Wide-field fundus image from infant ROP screening · captured with the Clarity RetCam 3 (130° field of view) · 640x480.
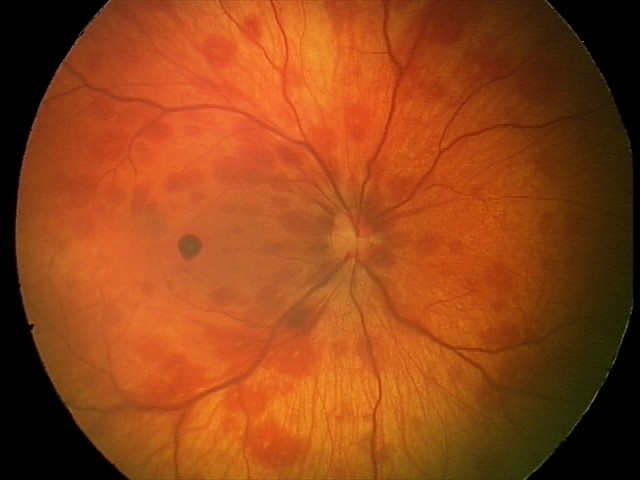
Assessment: retinal hemorrhages.